2352x1568px, 45° field of view
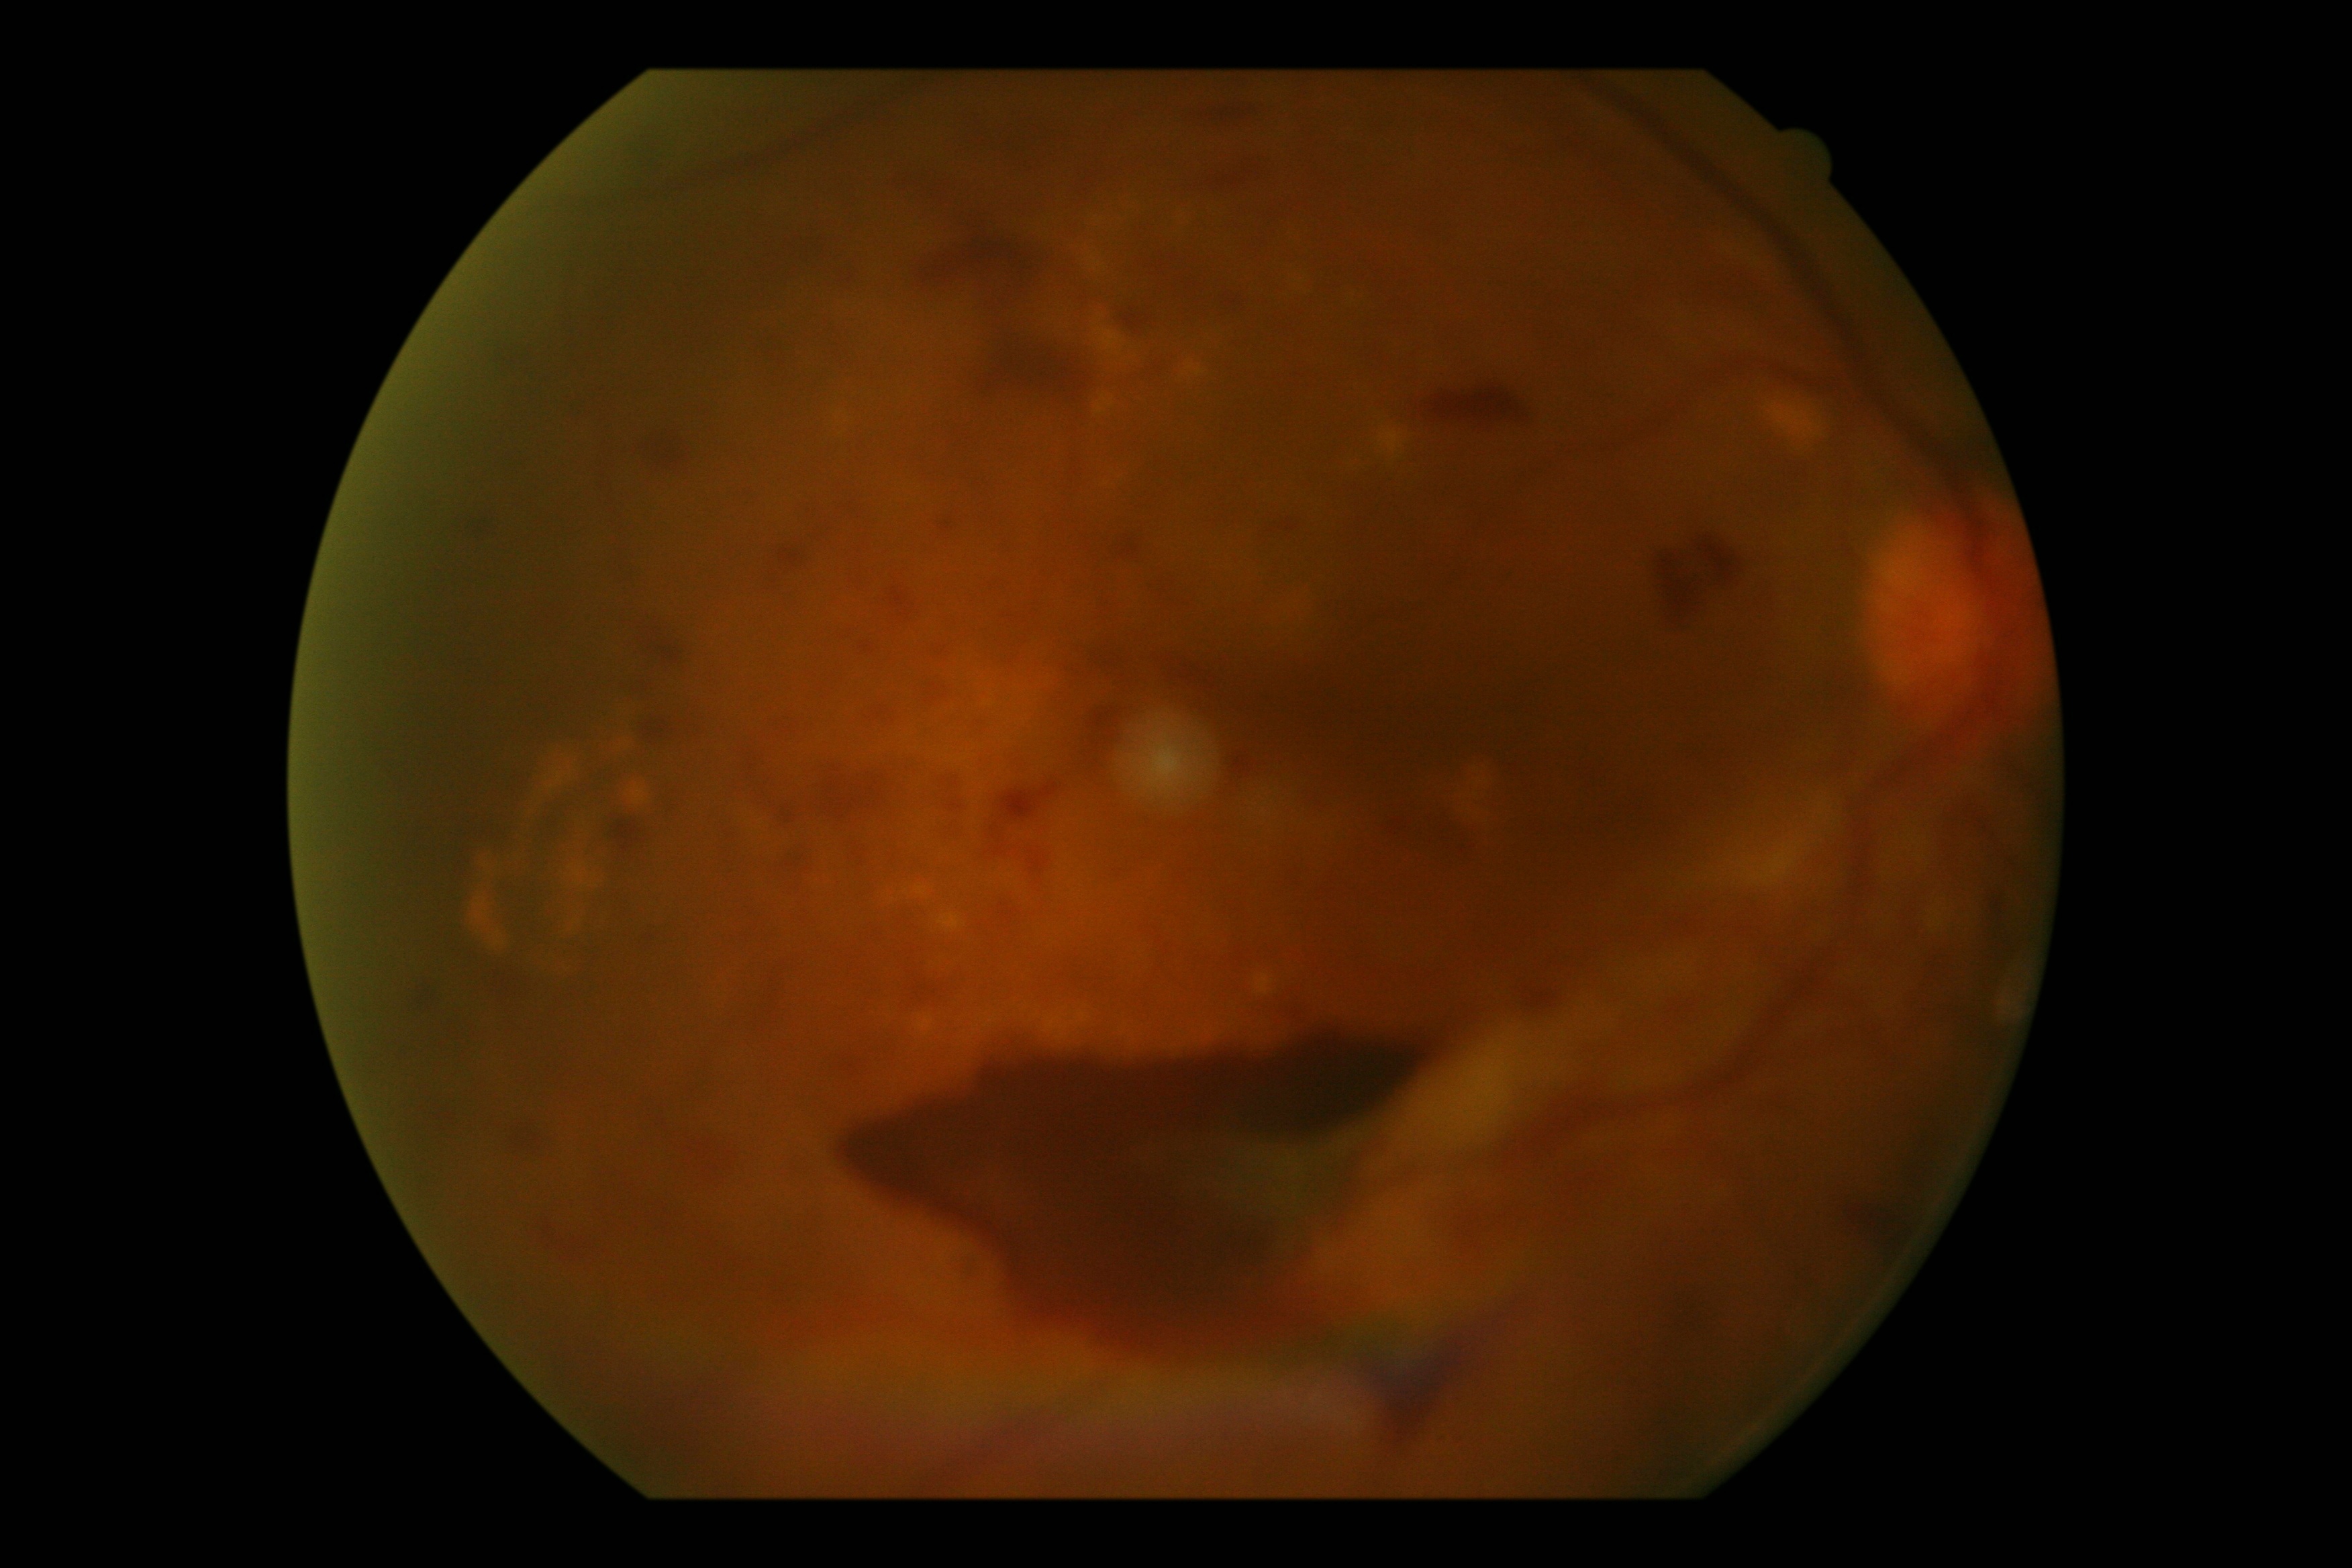
DR grade: proliferative diabetic retinopathy (4).